Image size 1240x1240 · wide-field contact fundus photograph of an infant.
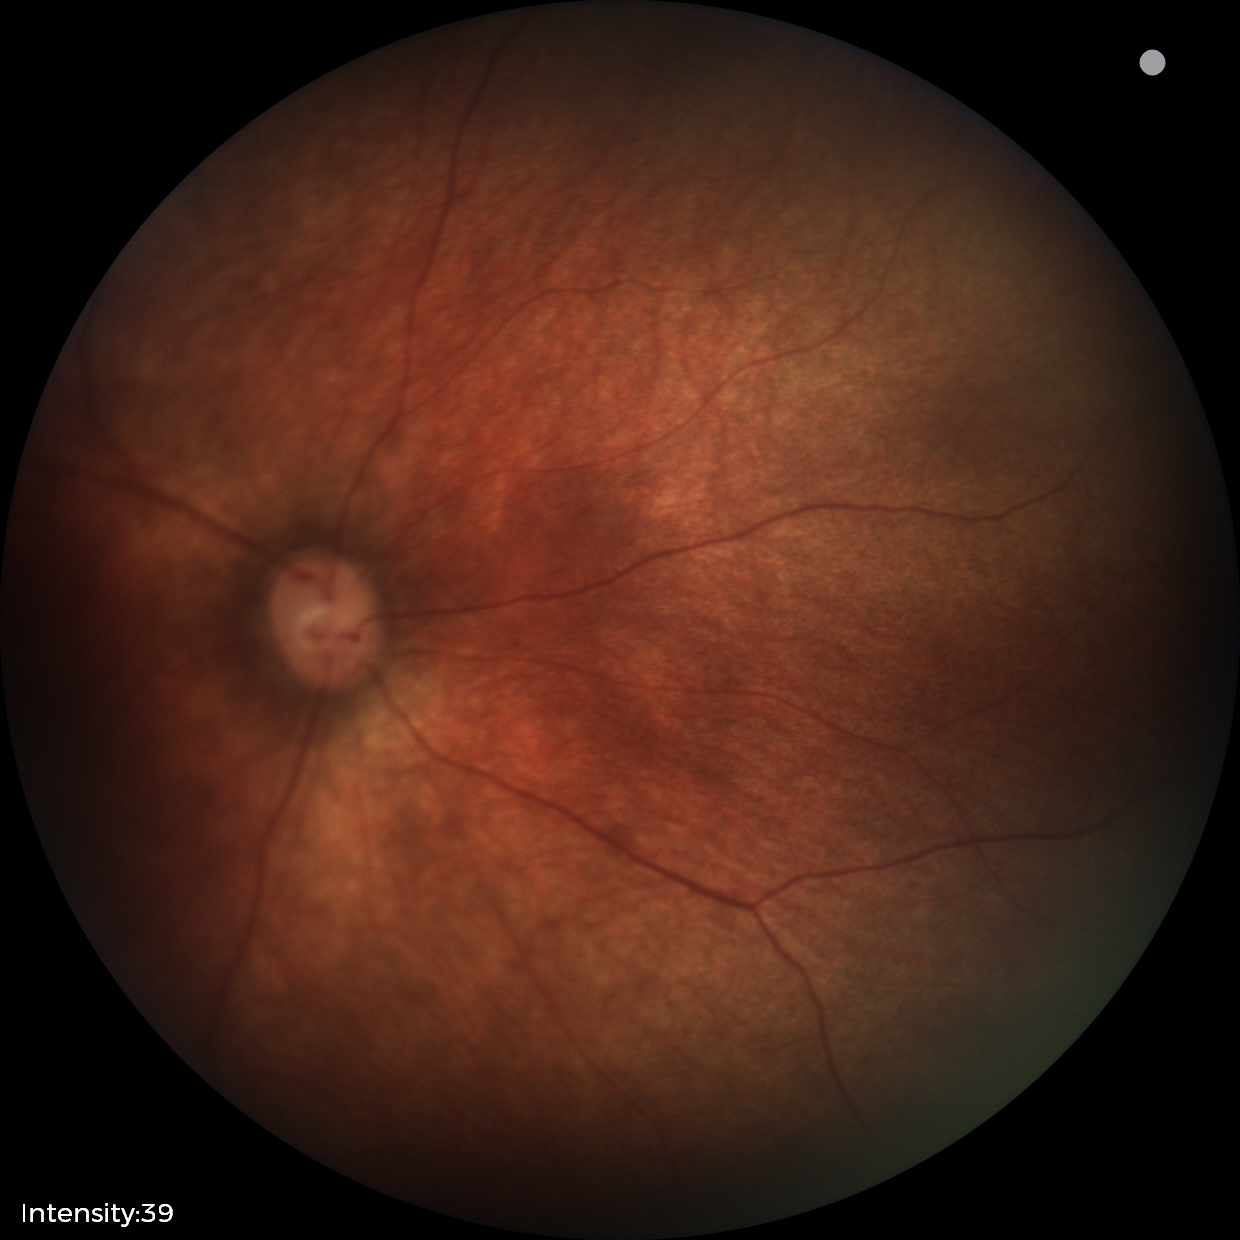
Physiological retinal appearance for postconceptual age.